45-degree field of view. 2346x1568px. Retinal fundus photograph:
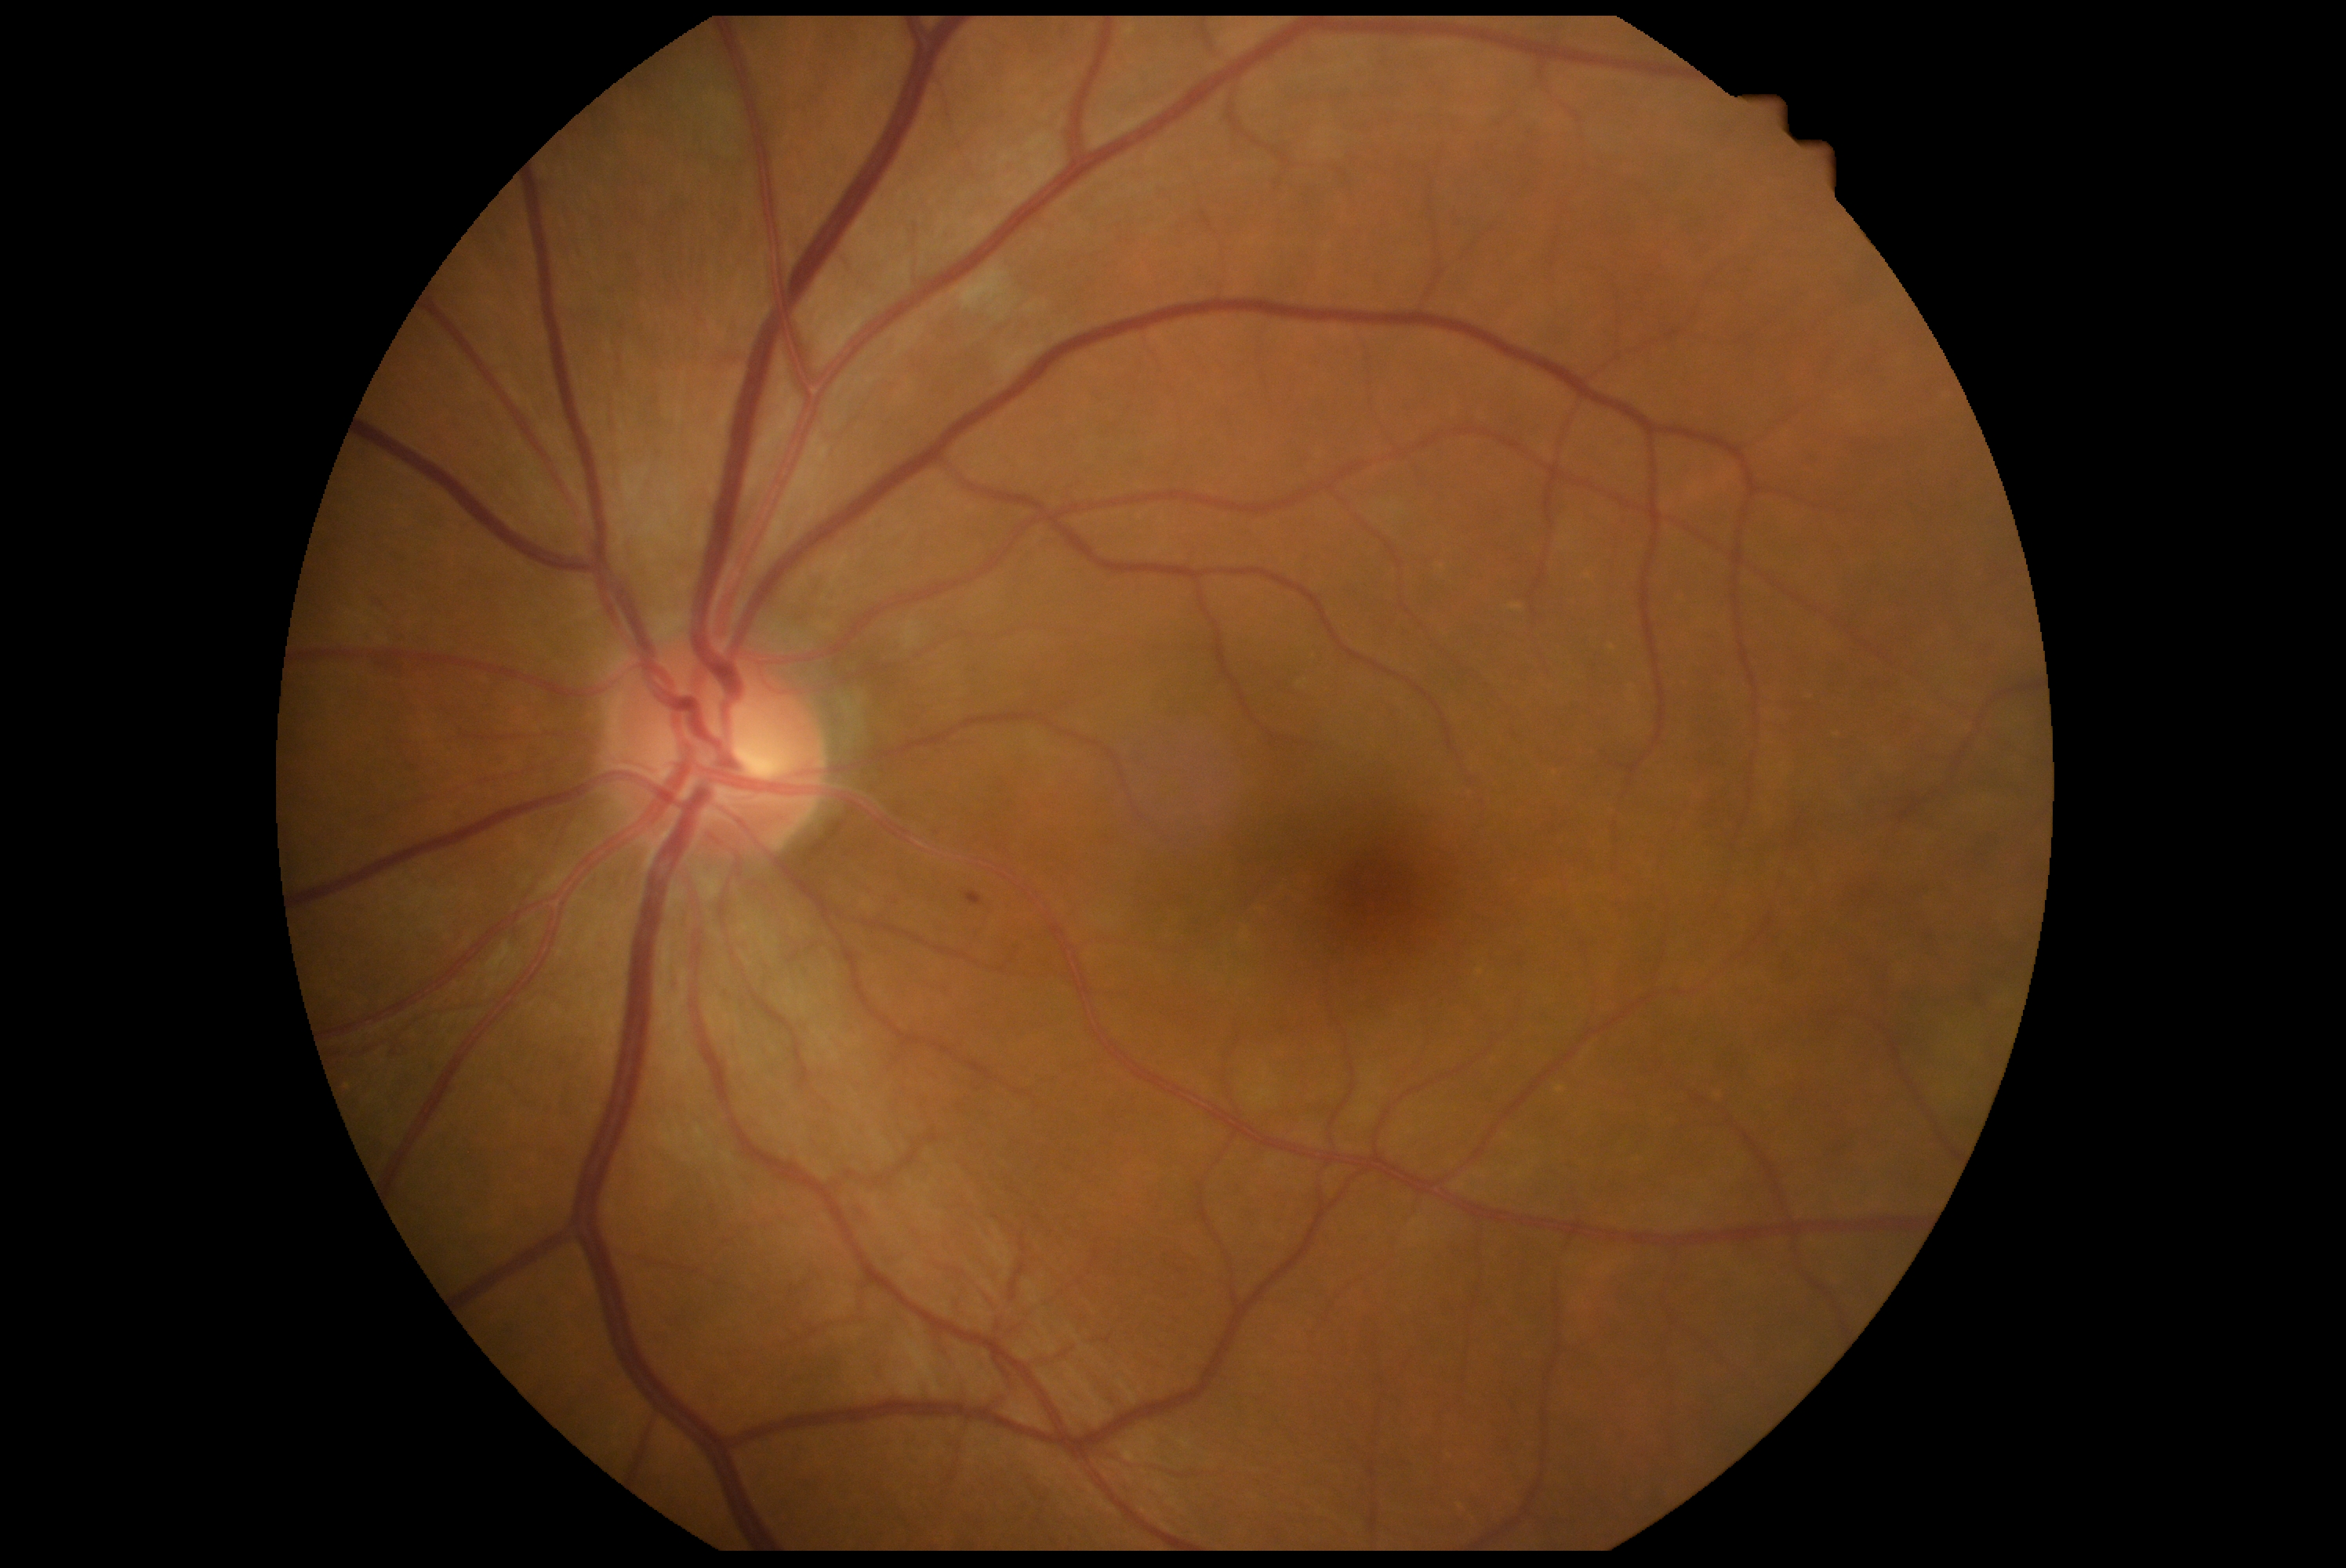

The retinopathy is classified as non-proliferative diabetic retinopathy. Diabetic retinopathy (DR): 2.